Retinal fundus photograph · image size 1932x1910:
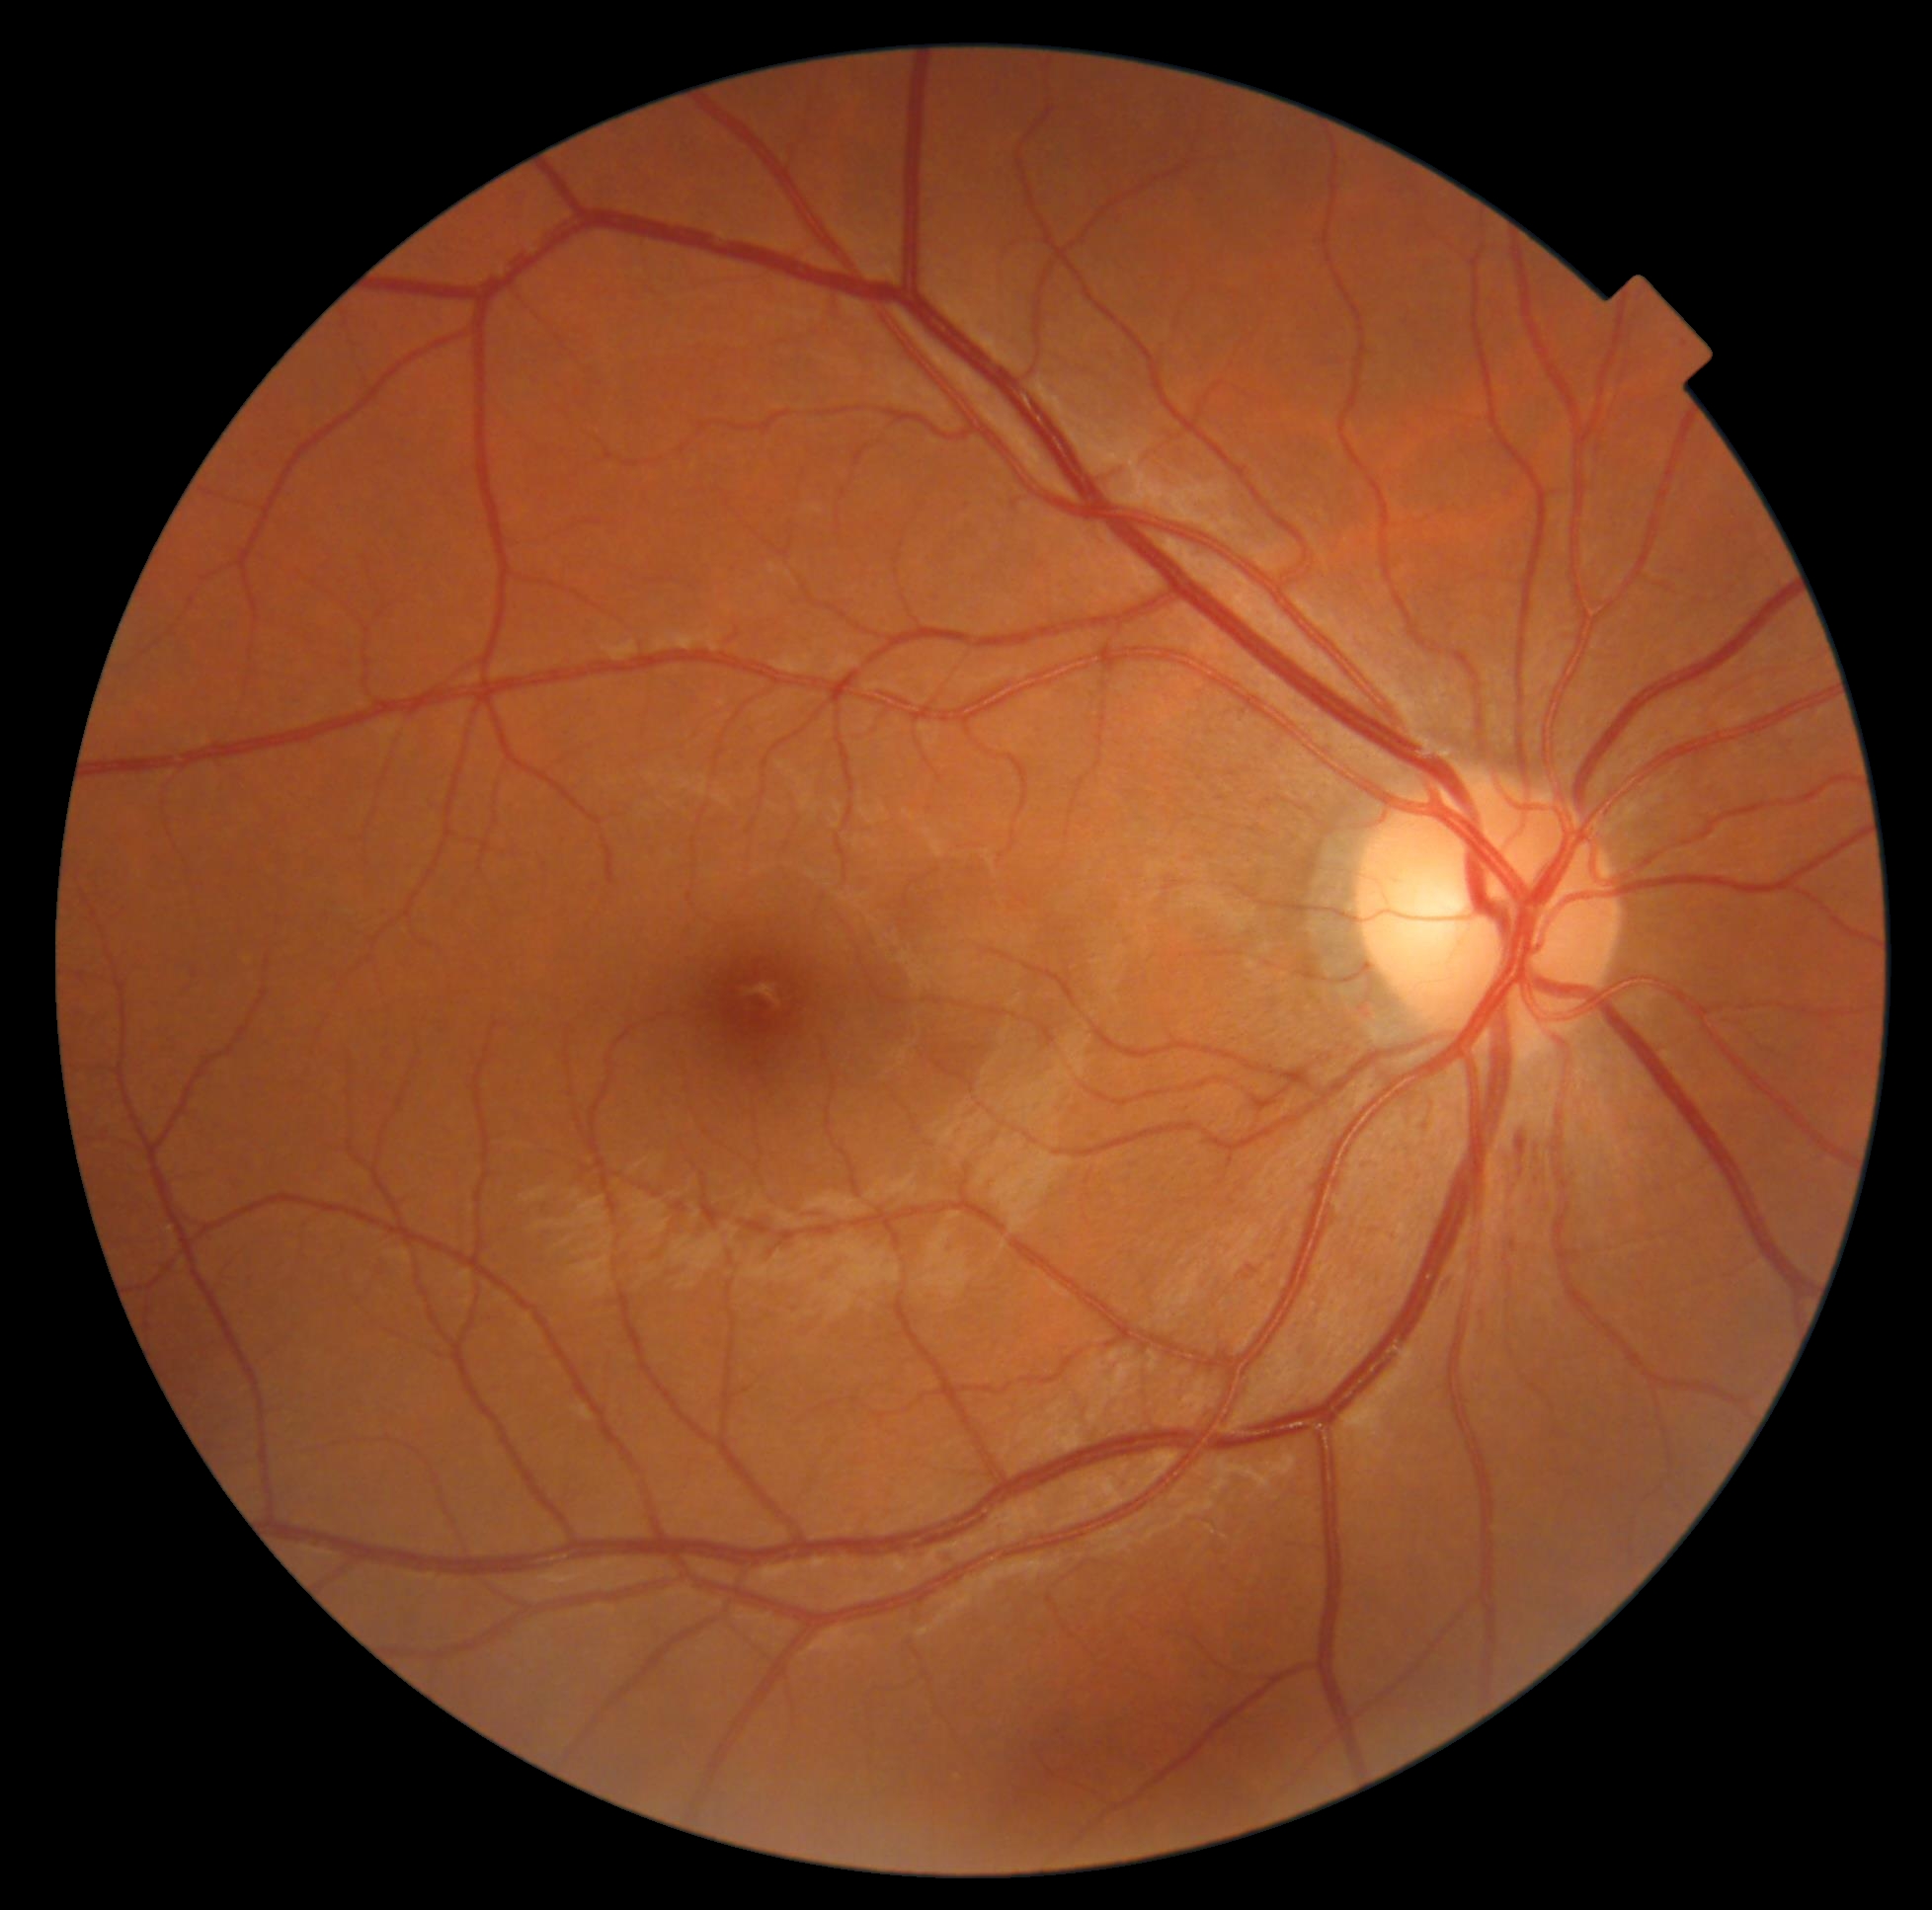 Diabetic retinopathy severity: 2.
Disease class: non-proliferative diabetic retinopathy.